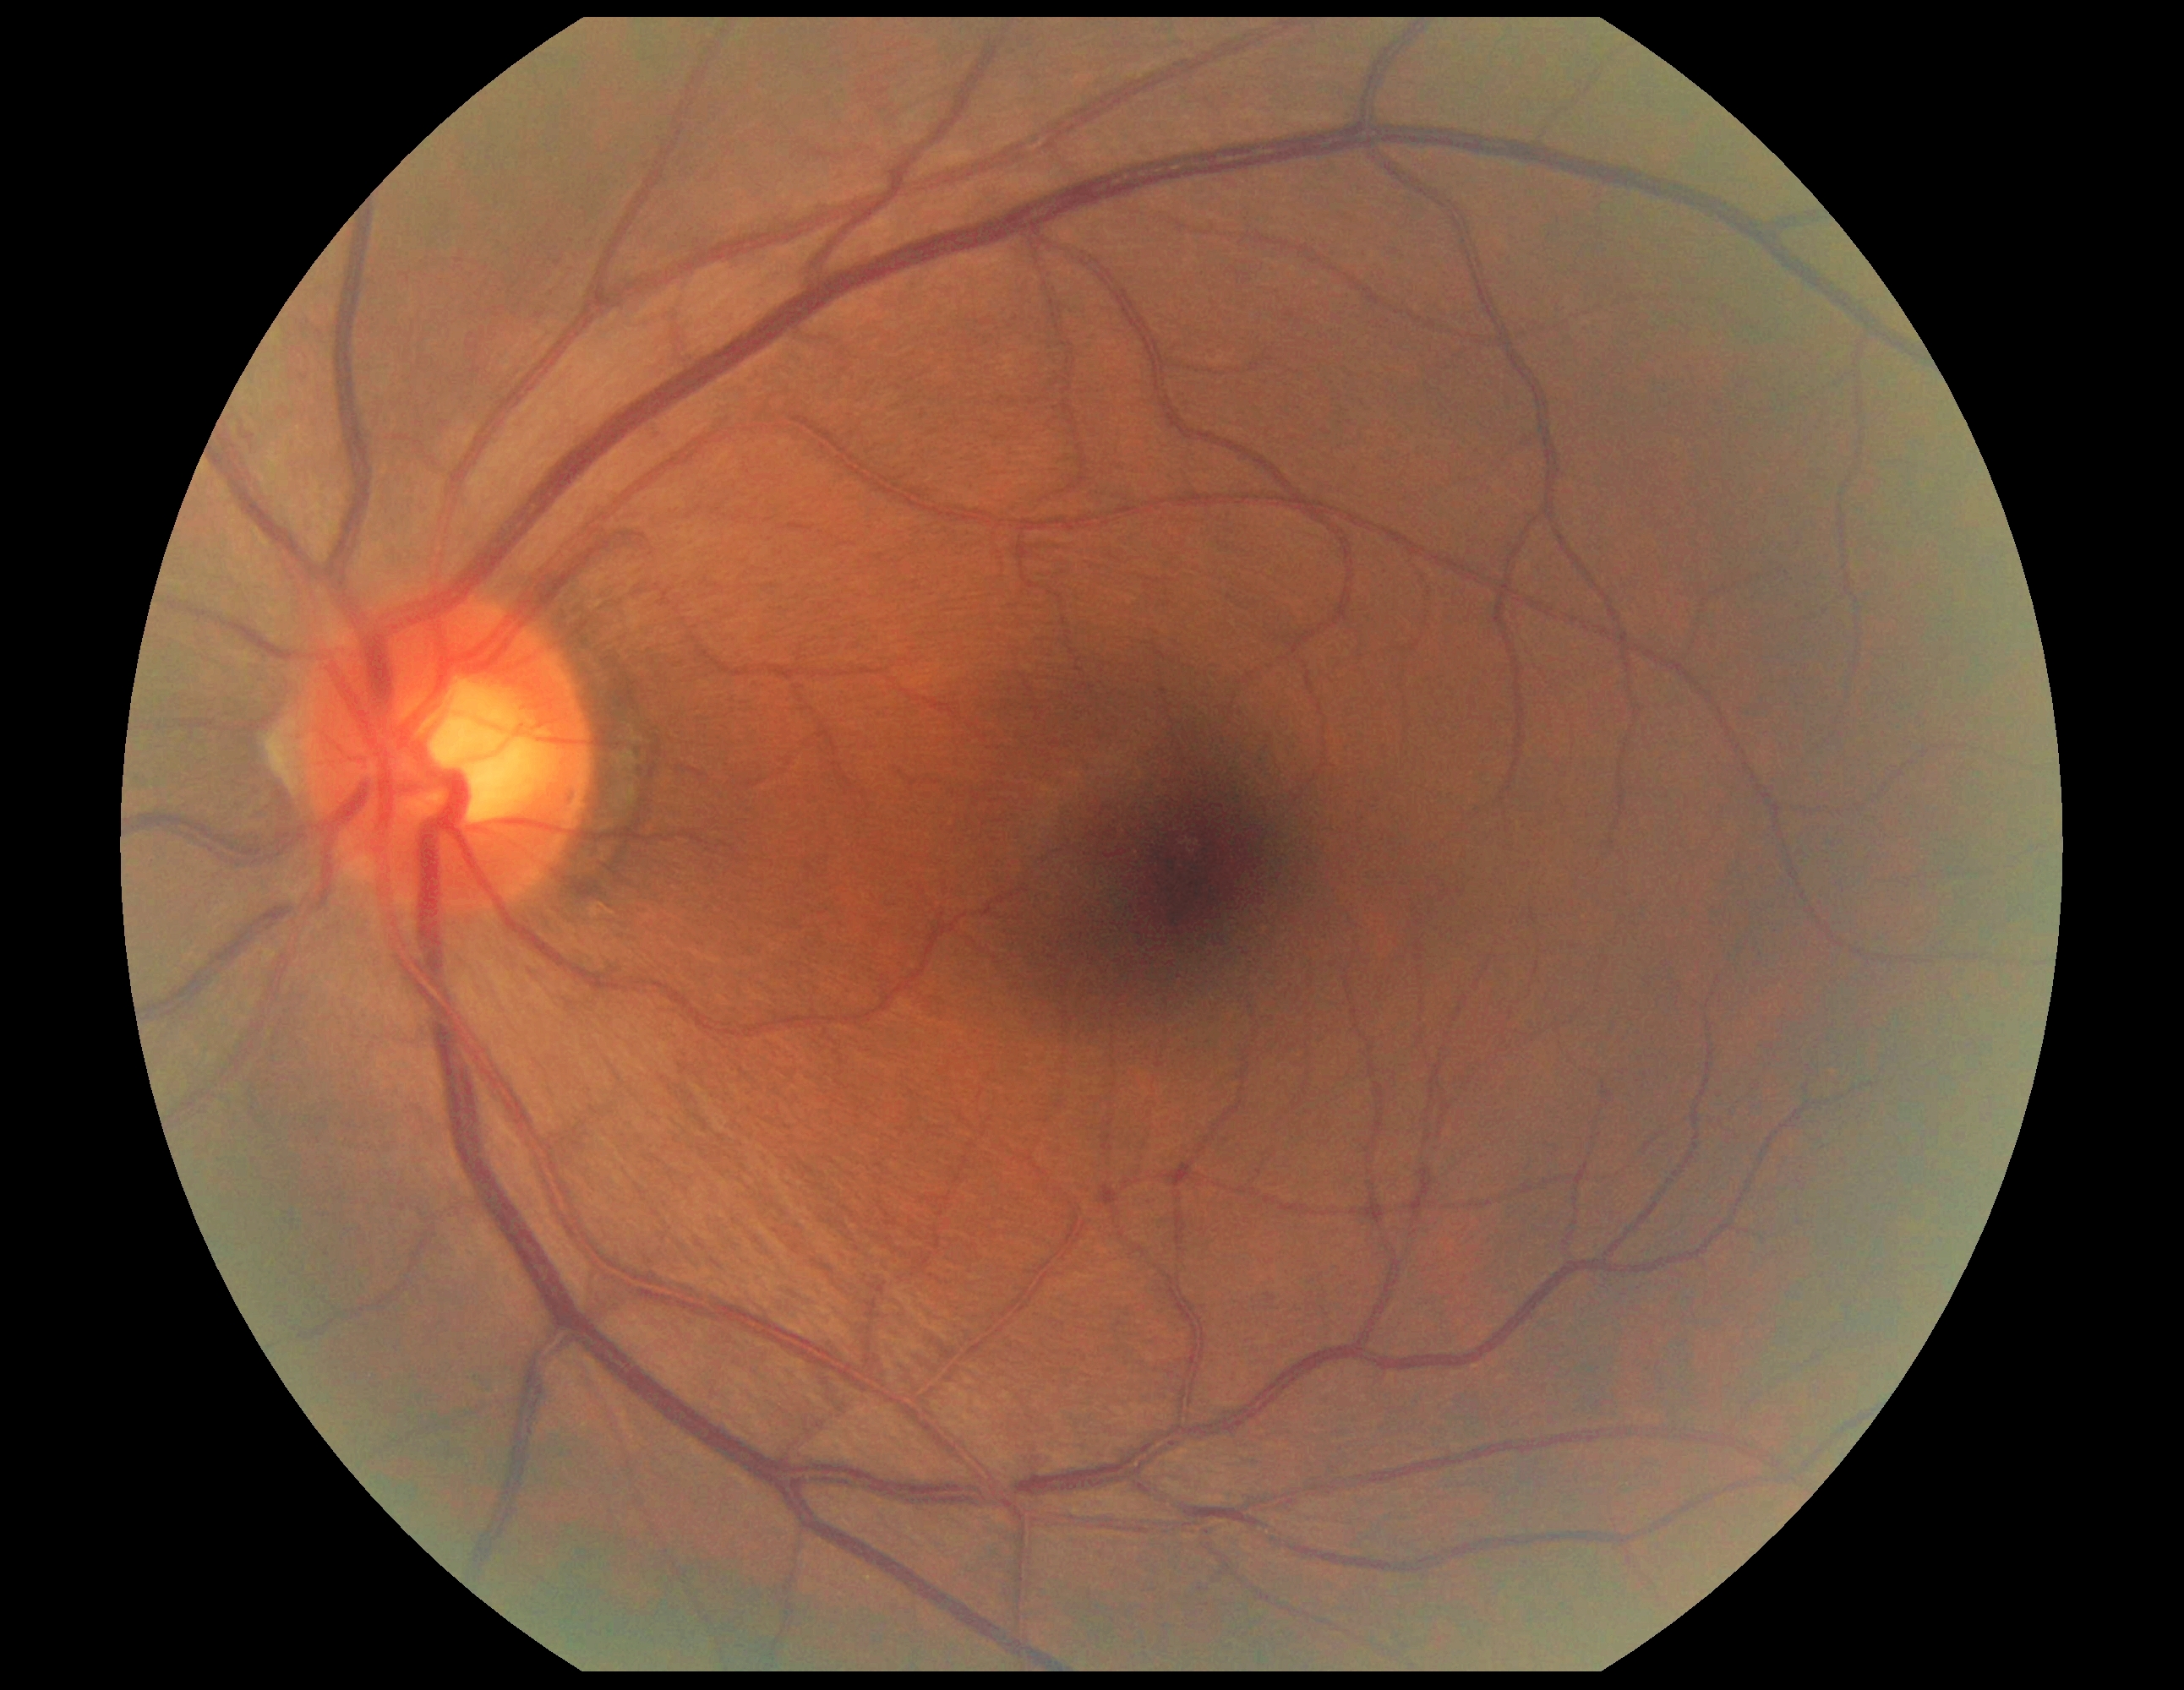

DR severity is no apparent diabetic retinopathy (grade 0) — no visible signs of diabetic retinopathy.